45-degree field of view; 848x848px: 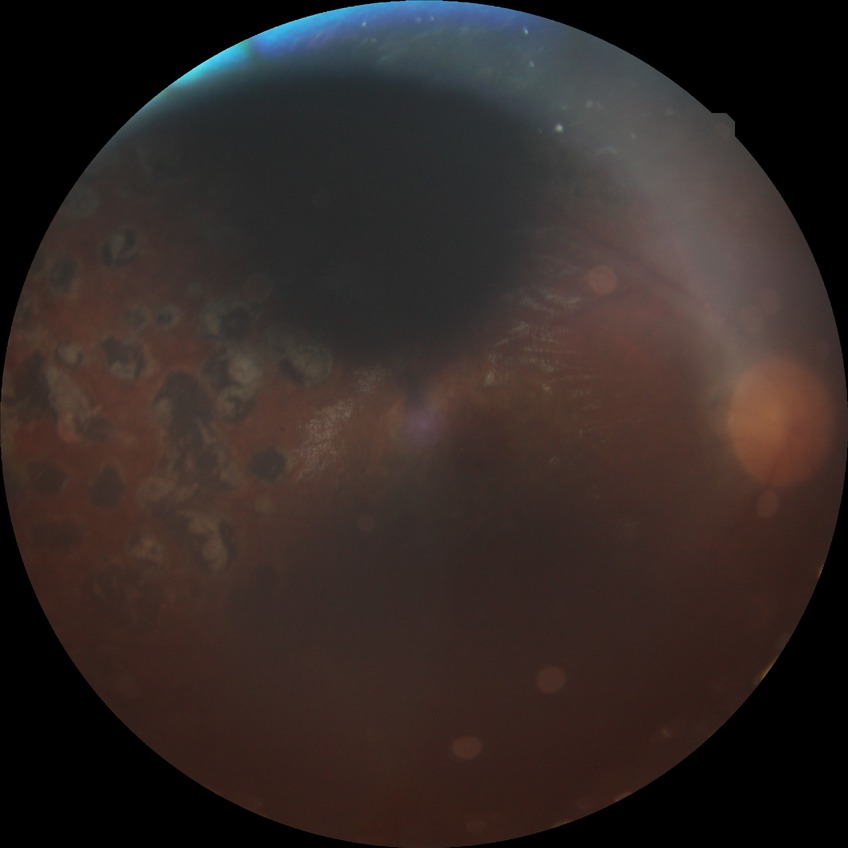 Davis DR grade: PDR.